45° FOV. Diabetic retinopathy graded by the modified Davis classification. NIDEK AFC-230 fundus camera — 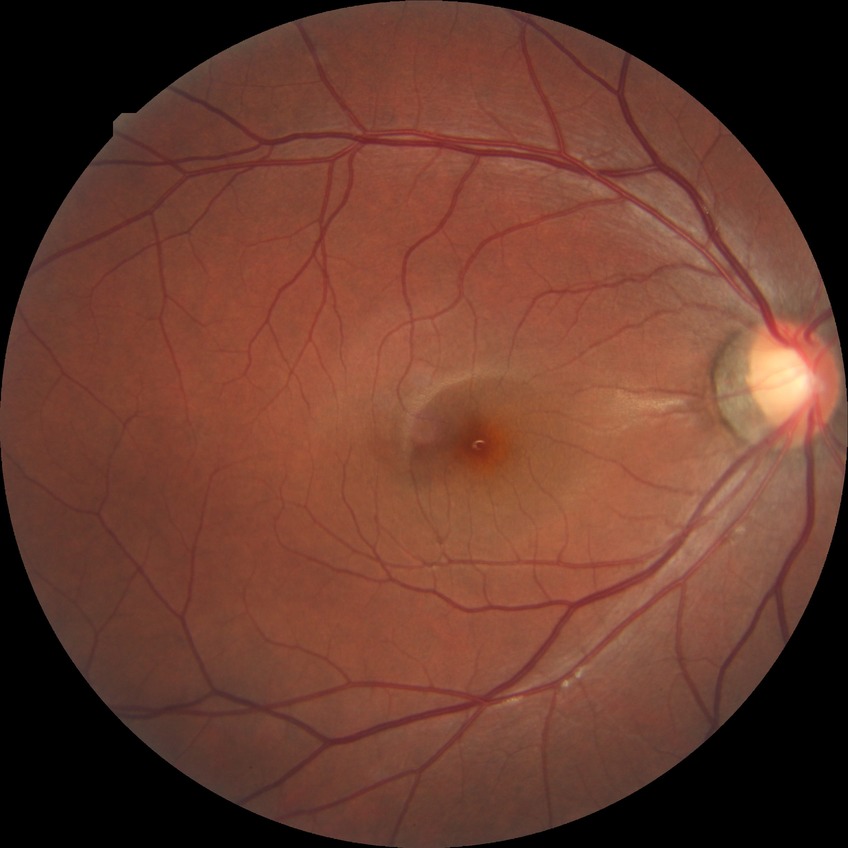 – Davis grading — no diabetic retinopathy